Pediatric retinal photograph (wide-field). Acquired on the Phoenix ICON
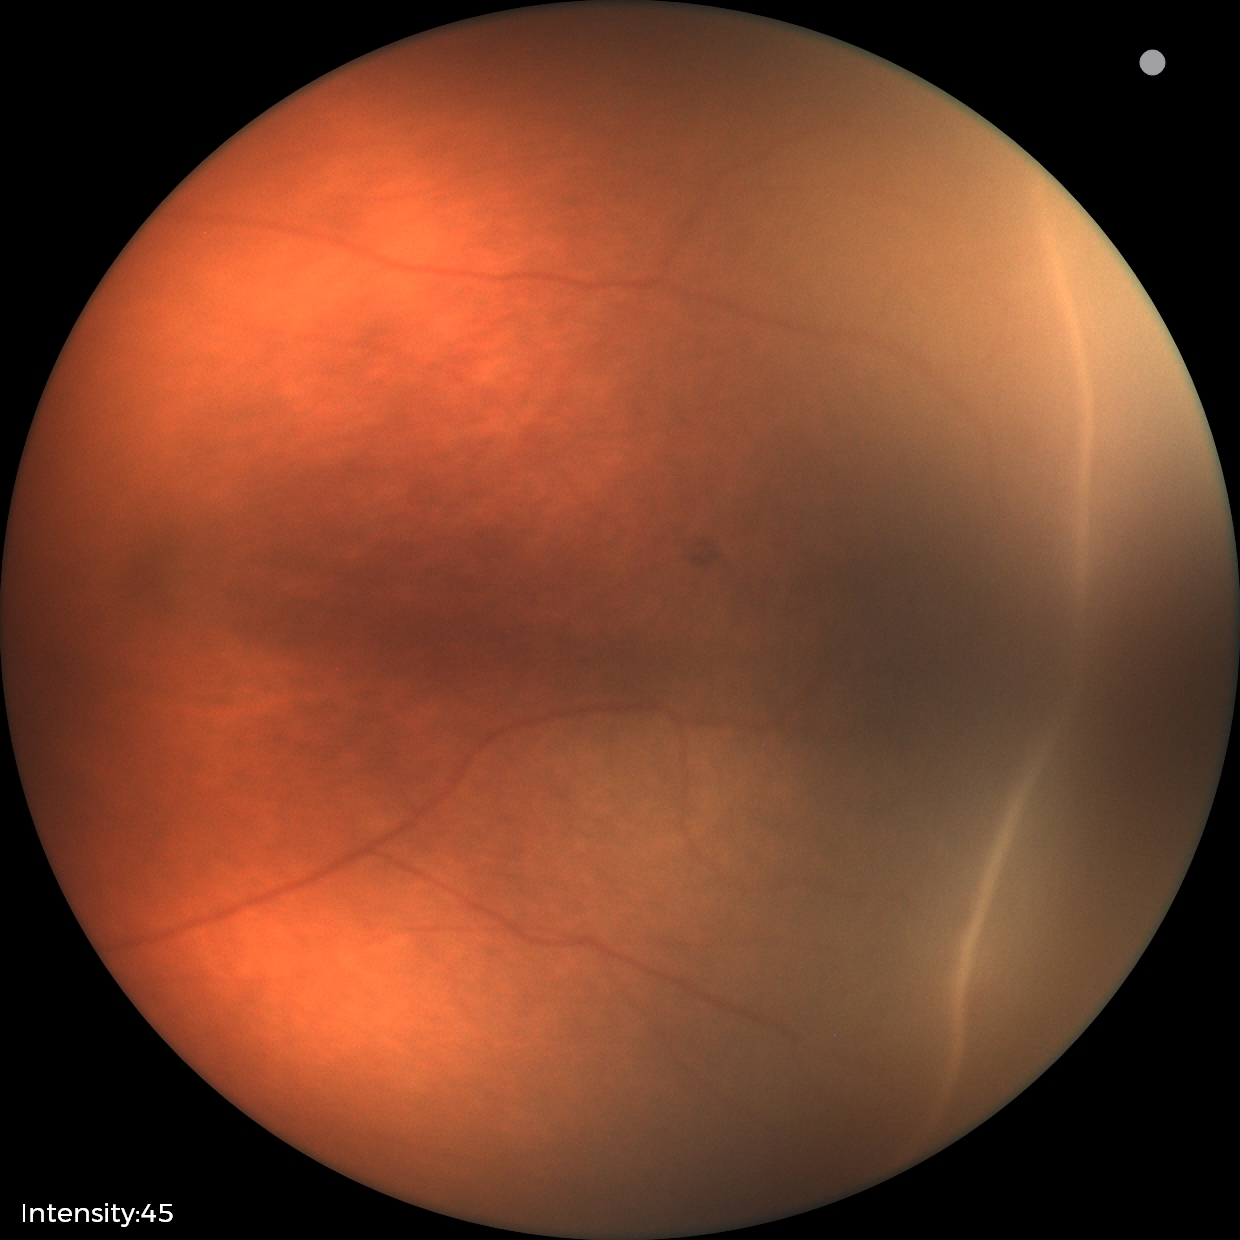
No plus disease. Screening series with ROP stage 2.